Captured after pupil dilation
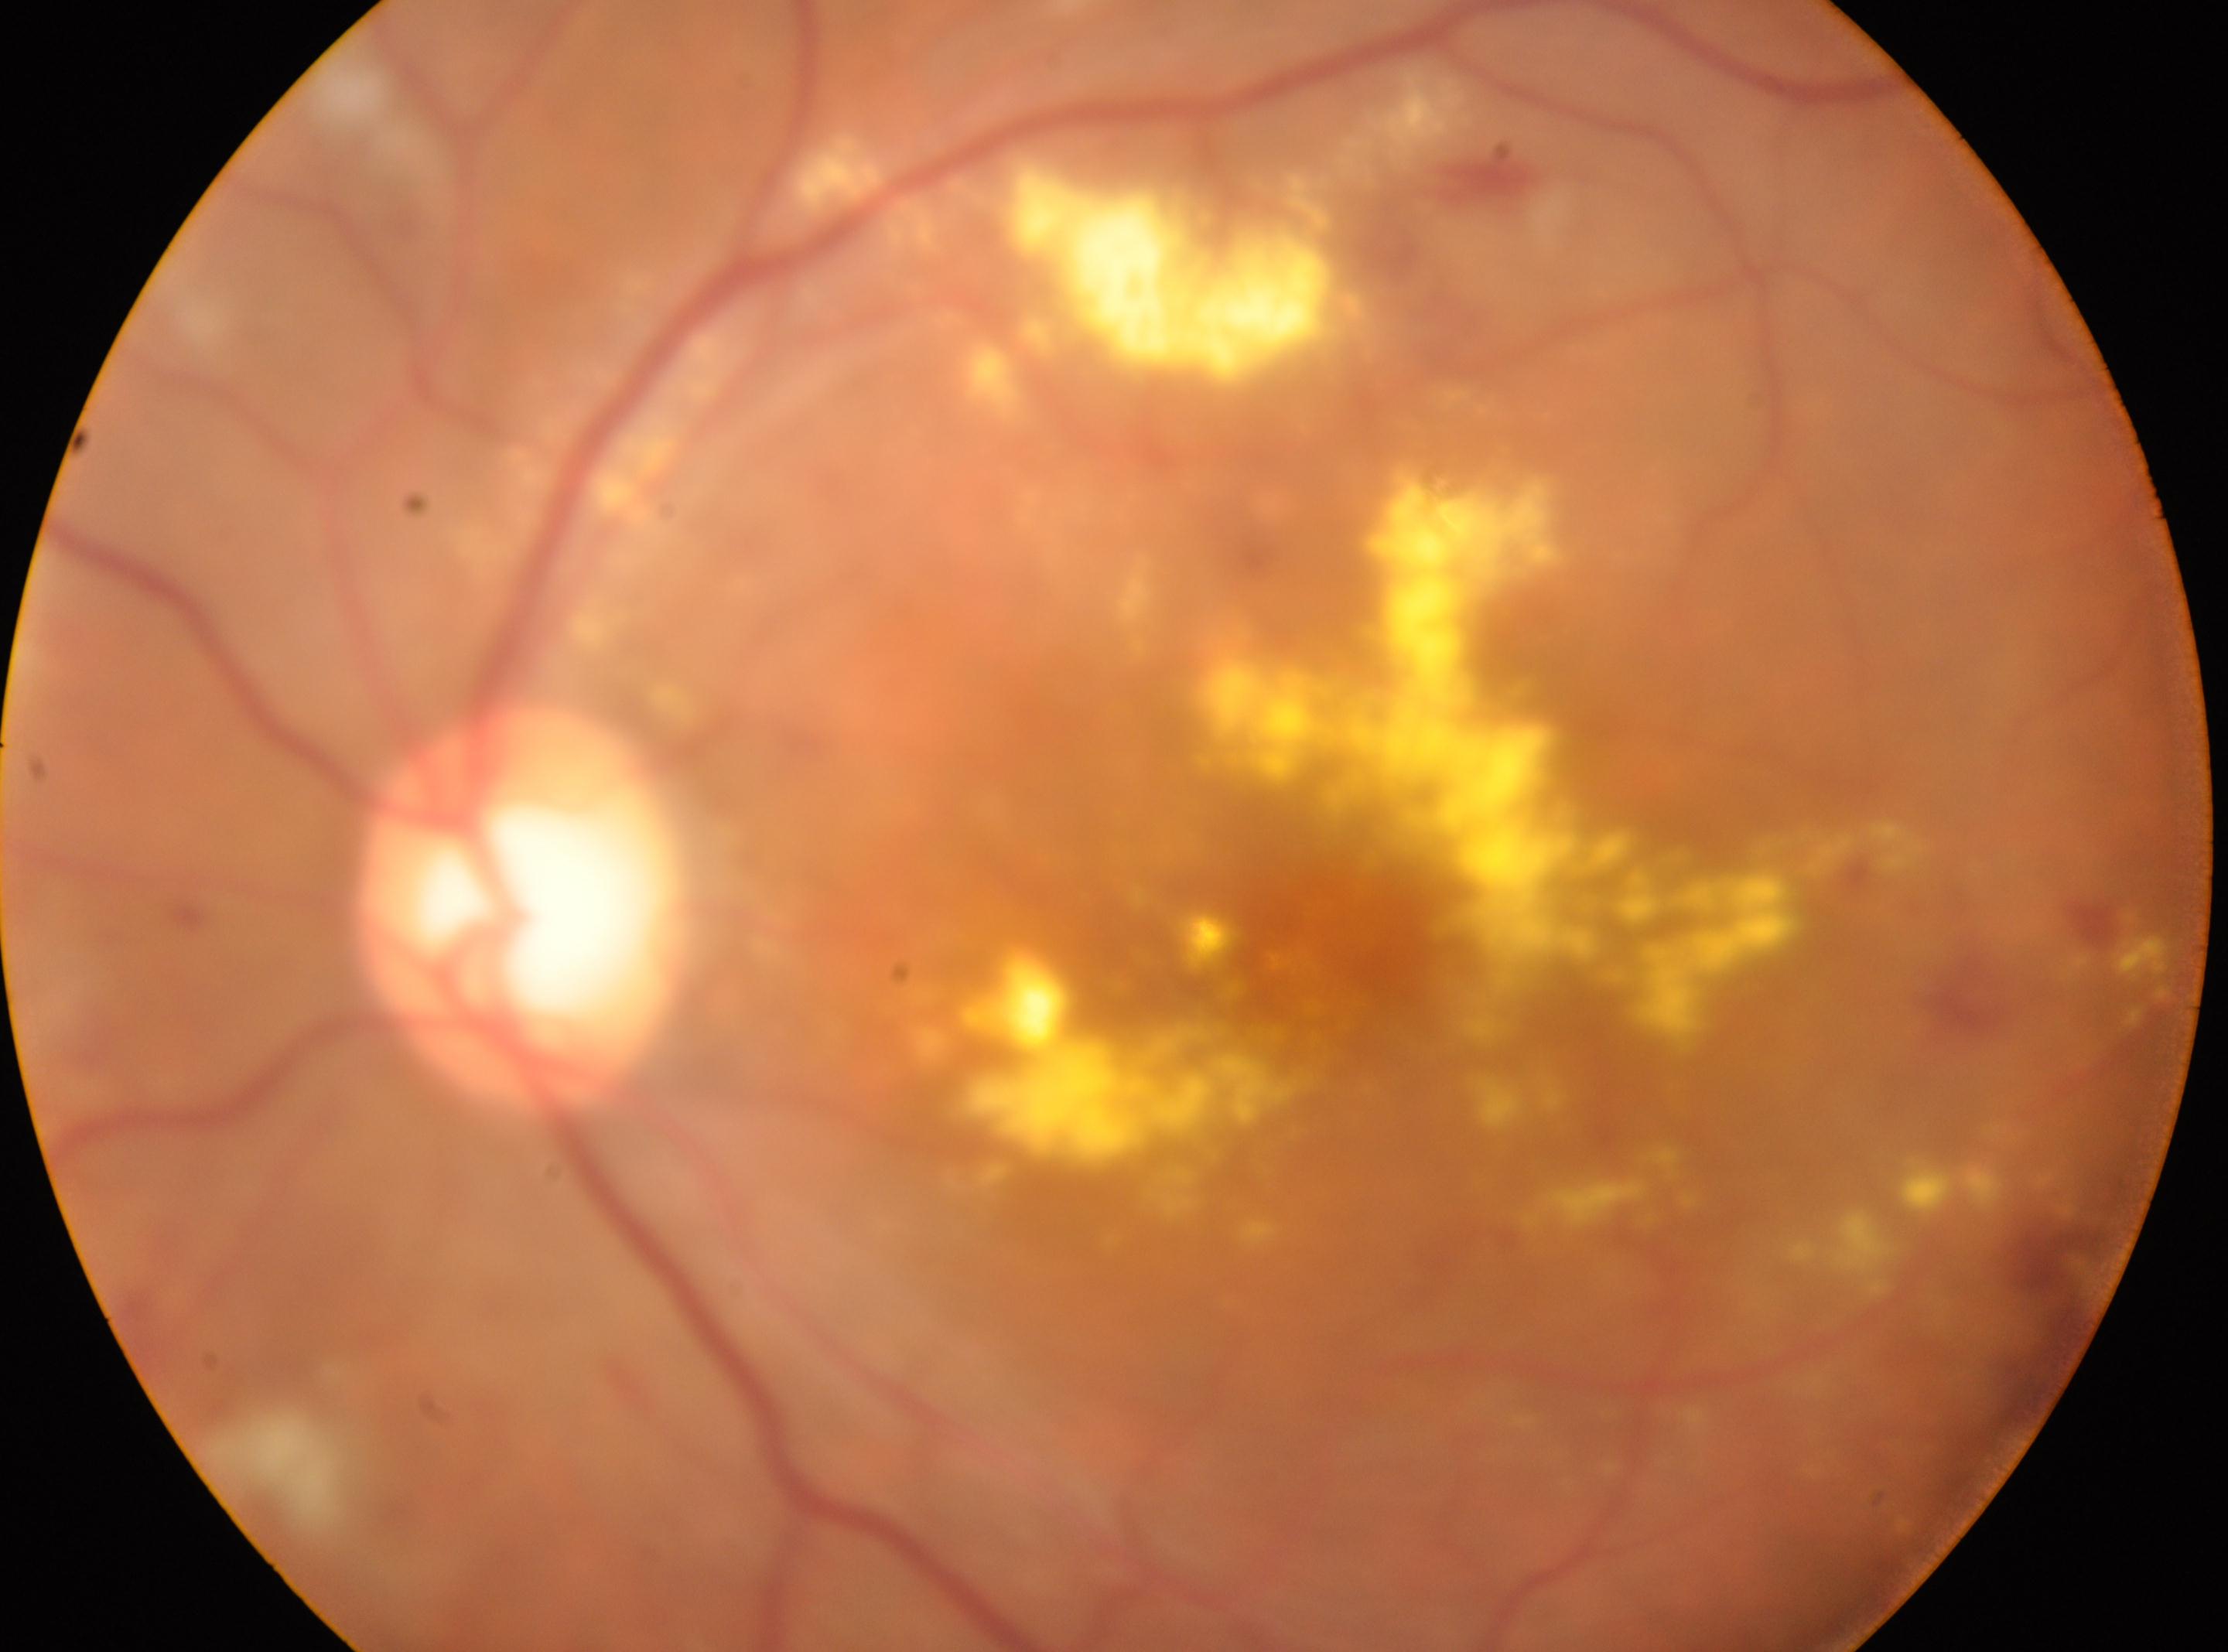 Annotations:
• laterality: the left eye
• optic nerve head: (518,910)
• diabetic retinopathy (DR): moderate NPDR (grade 2) — more than just microaneurysms but less than severe NPDR
• fovea centralis: (1314,931)